Pediatric retinal photograph (wide-field)
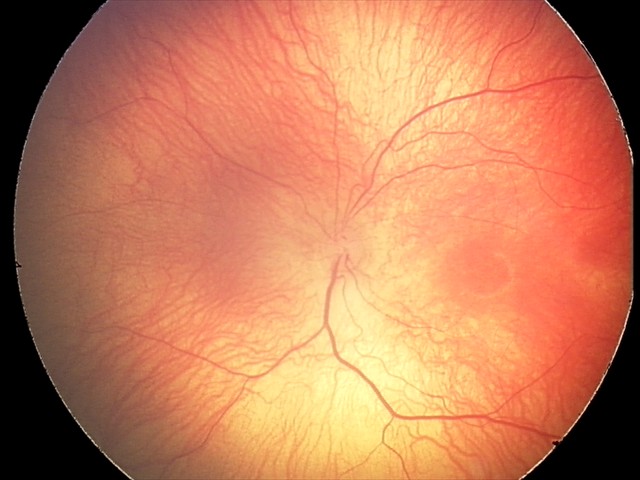 Q: Plus disease status?
A: no plus disease
Q: What is the screening diagnosis?
A: retinopathy of prematurity (ROP) stage 1